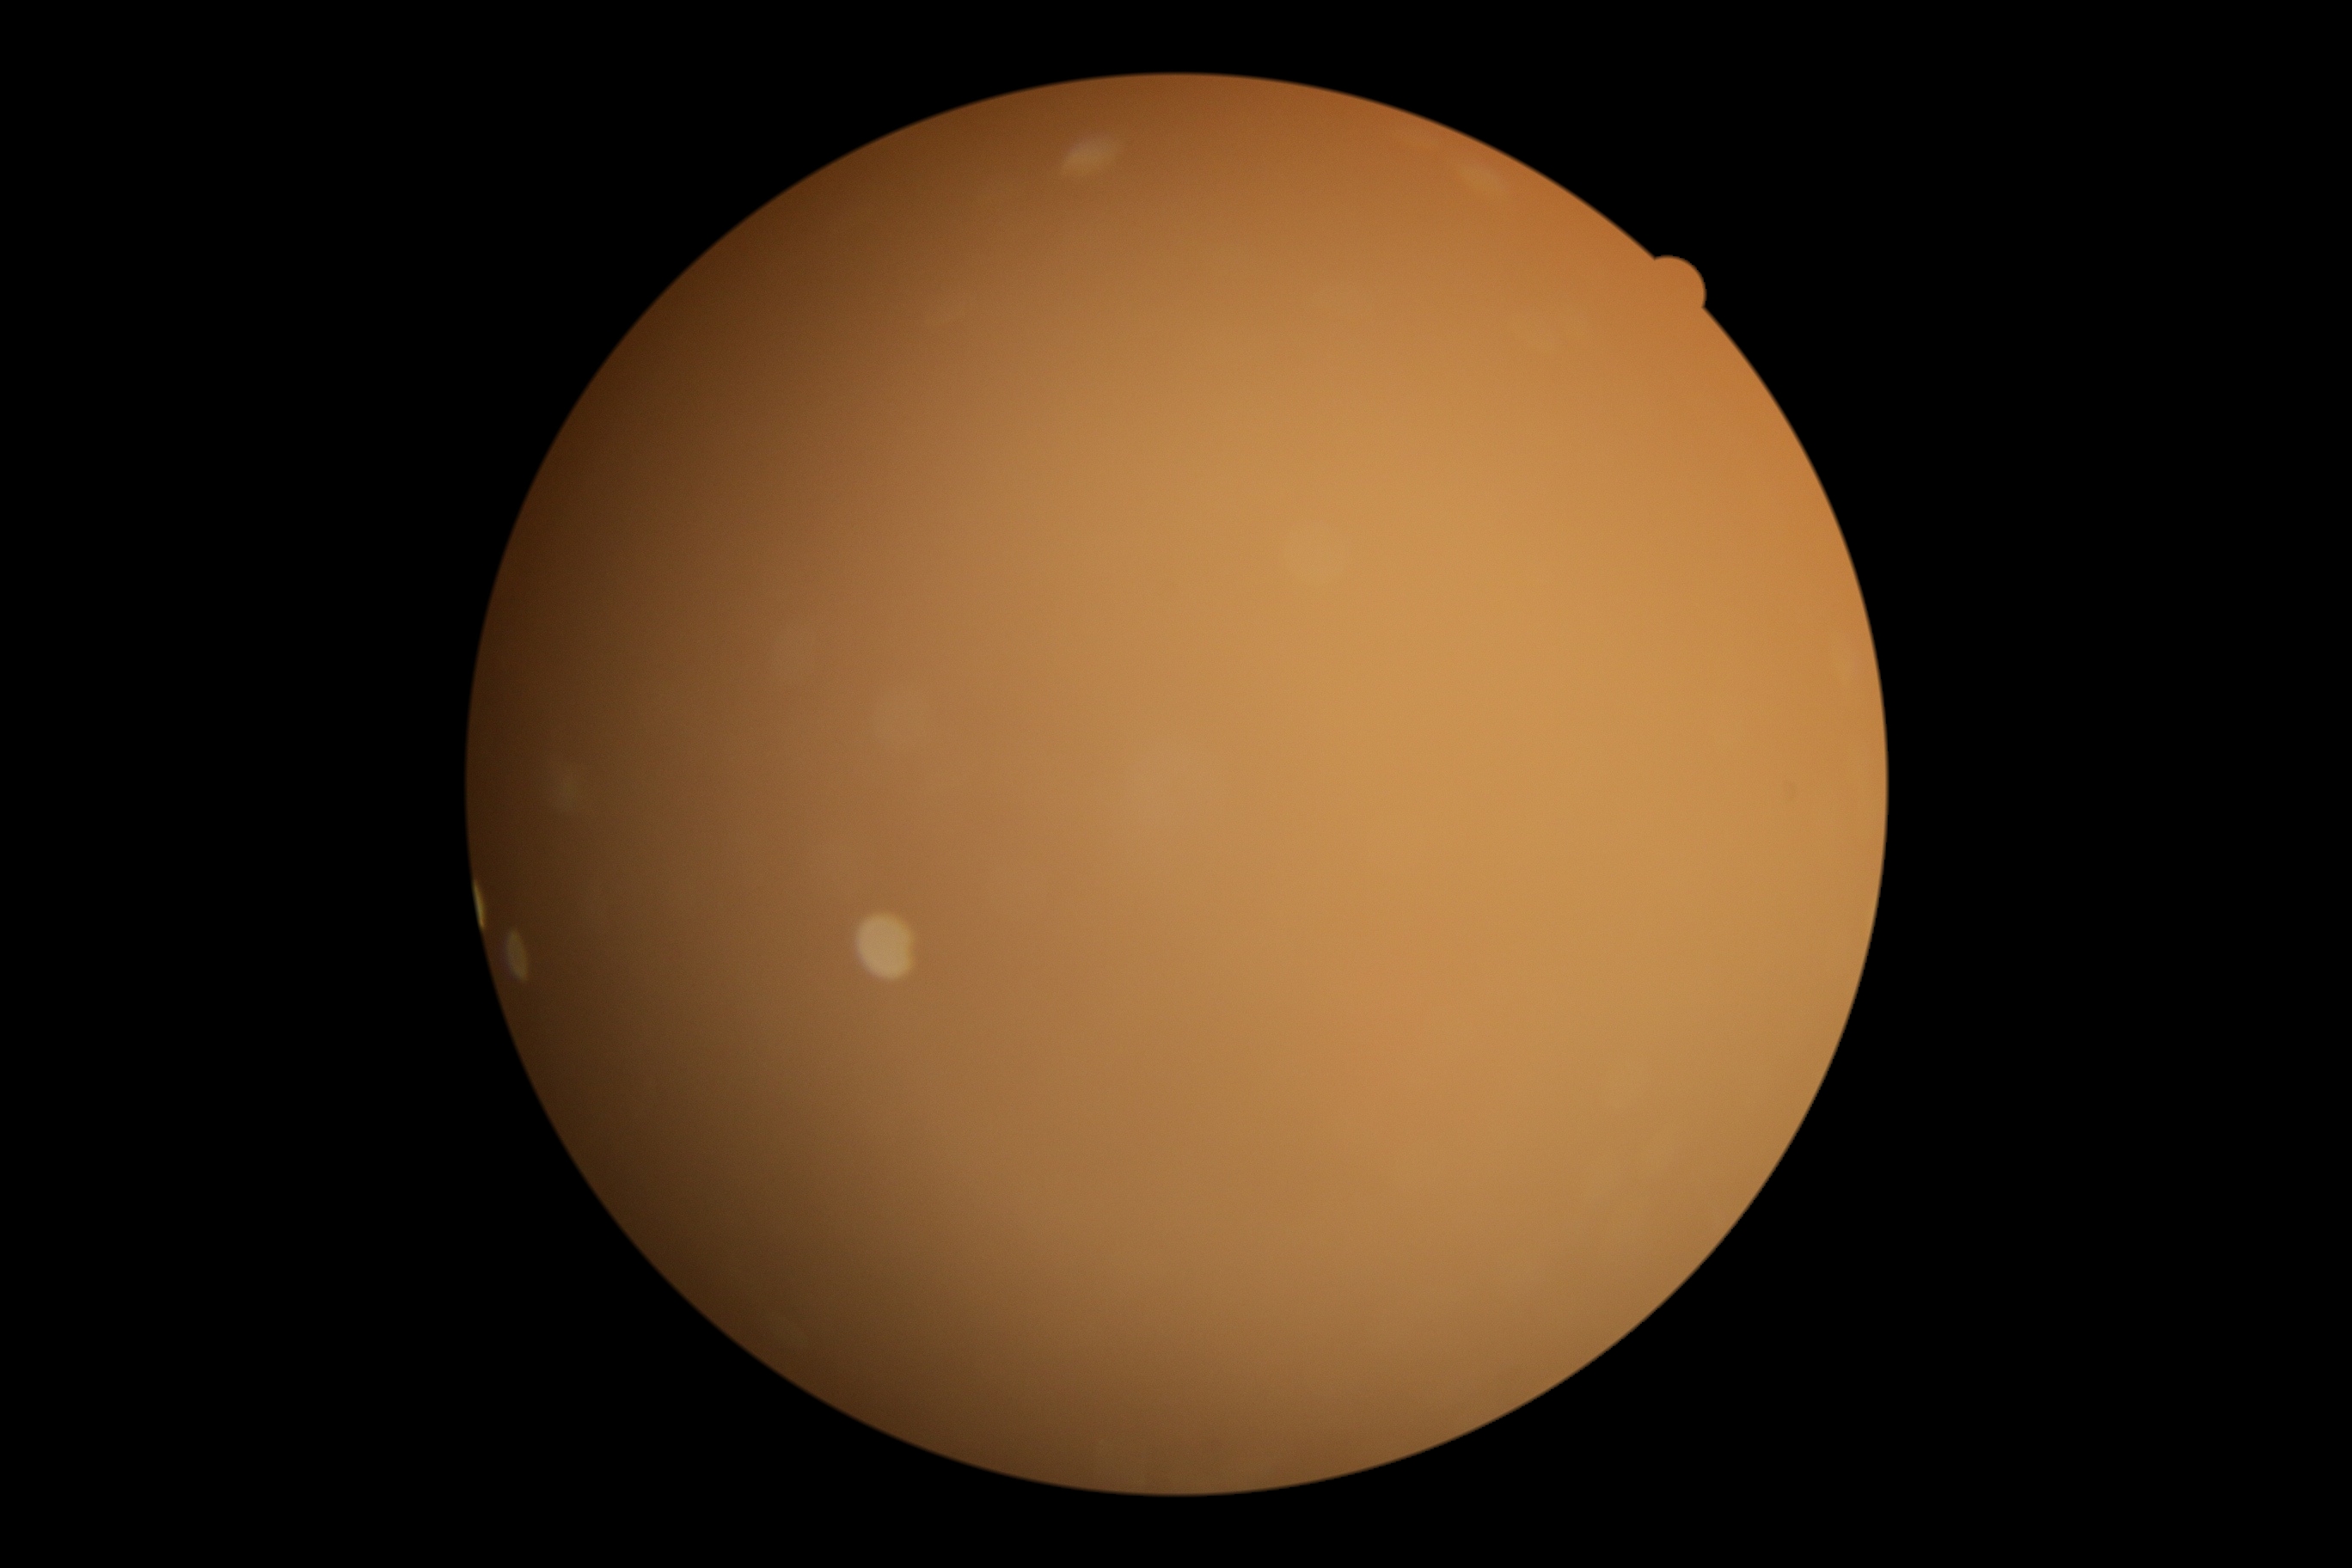

Diabetic retinopathy (DR) is ungradable.
Ungradable image — DR severity cannot be determined.